Acquired with a Forus 3Nethra Classic, fundus photo:
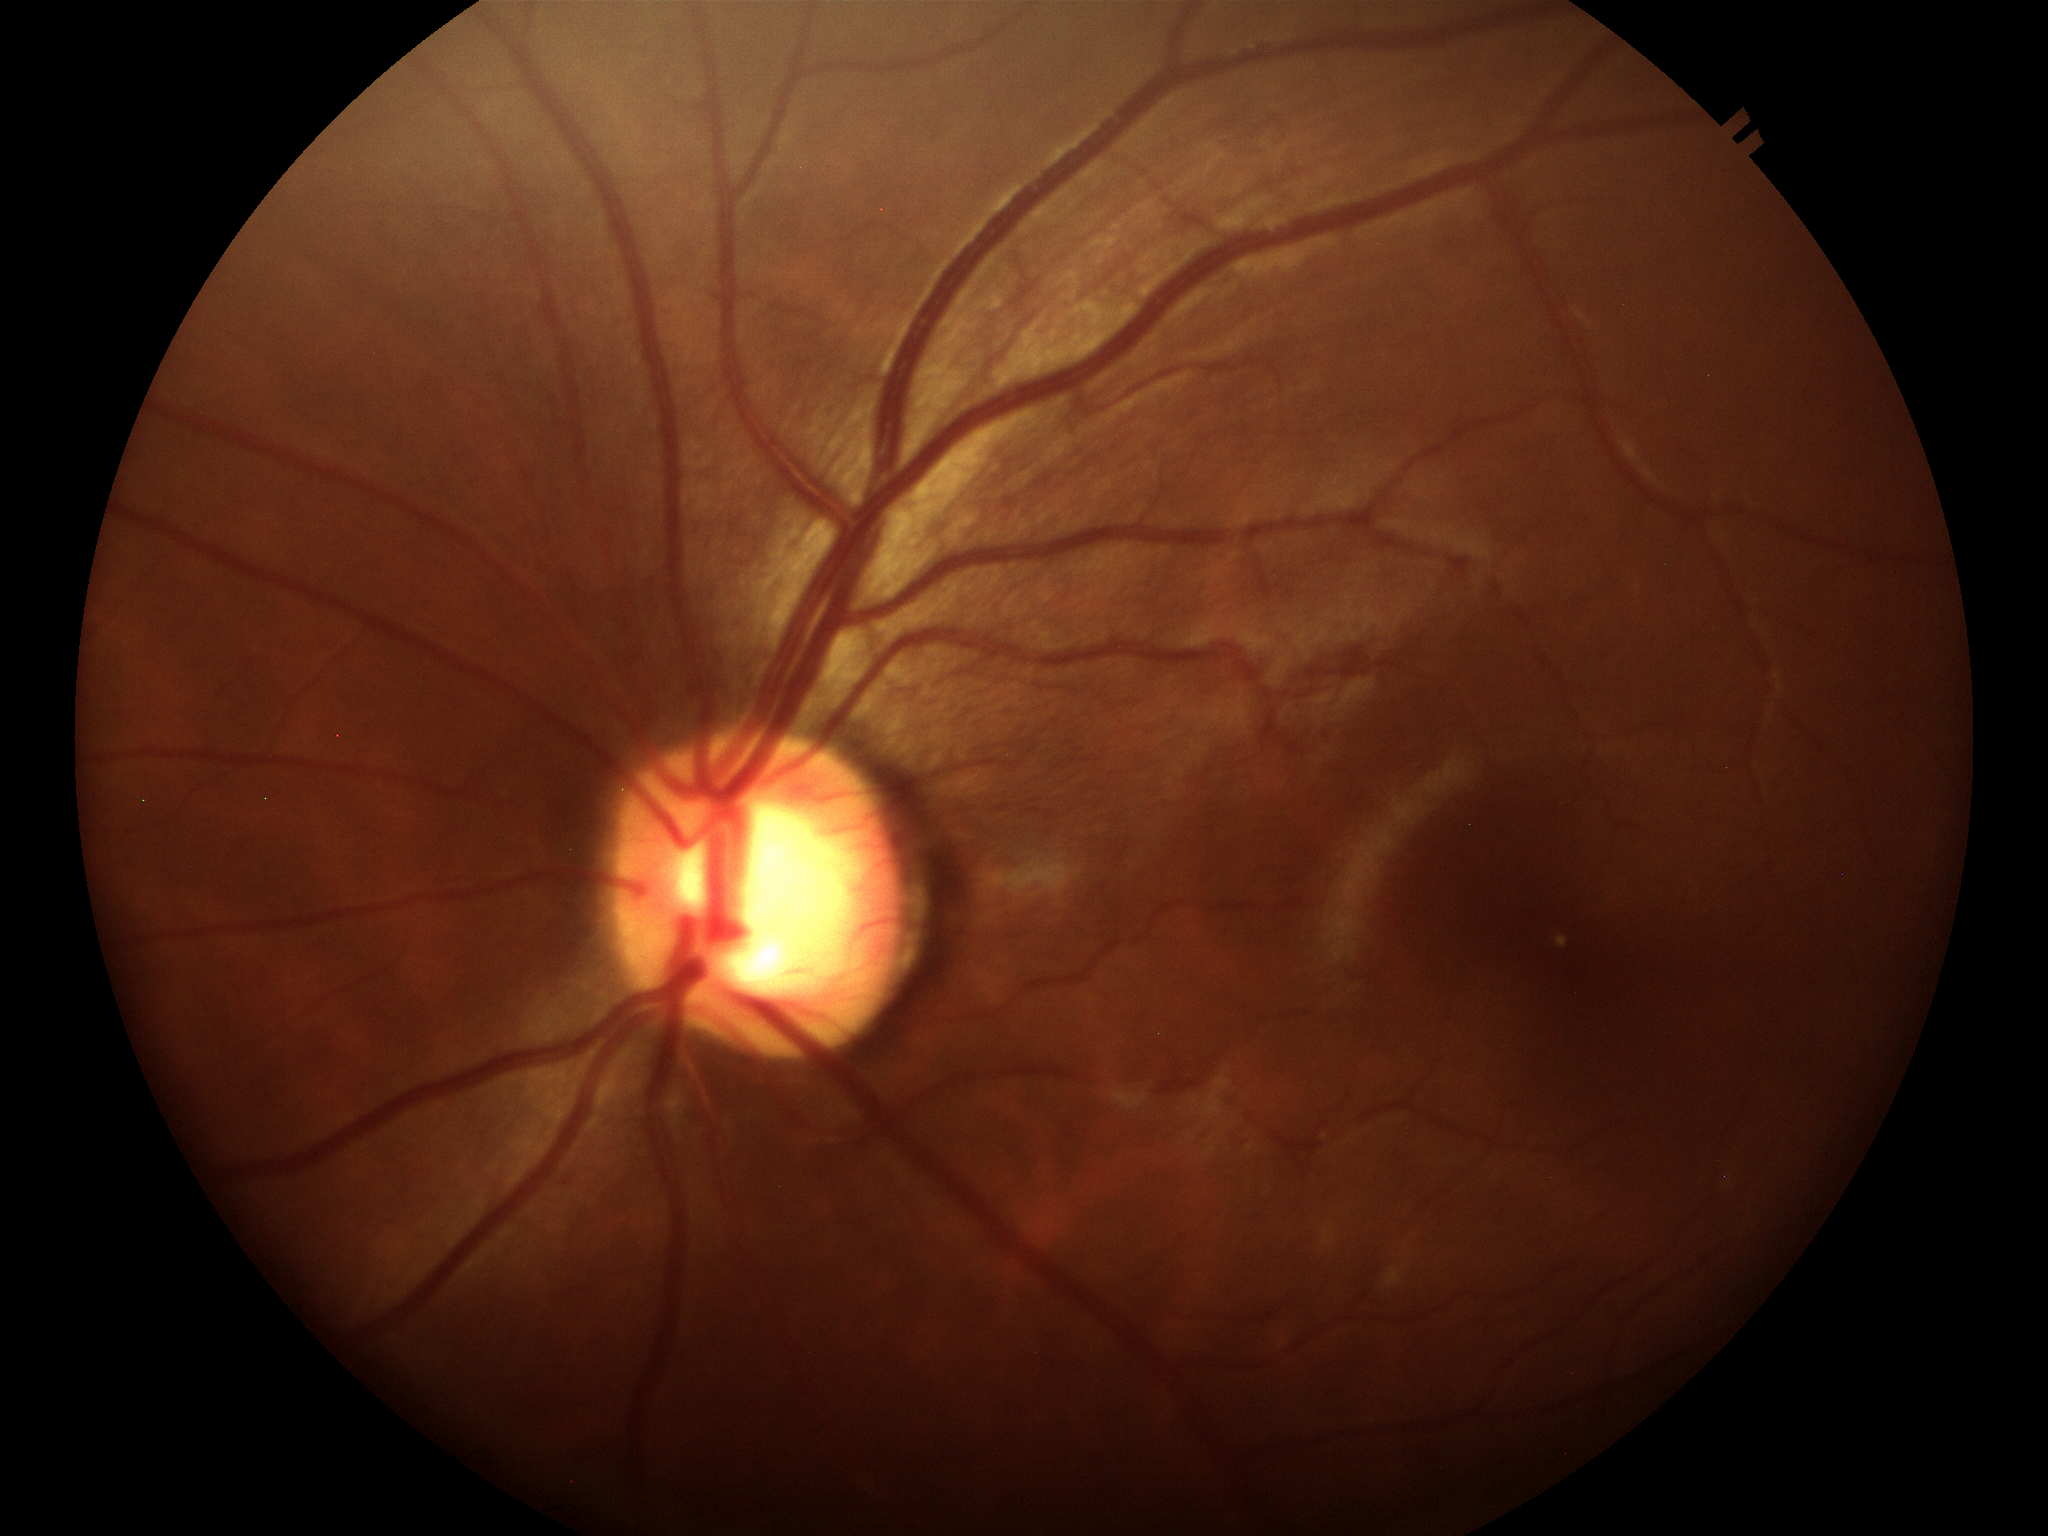 {"vcdr": "0.61", "glaucoma_decision": "suspicious findings"}